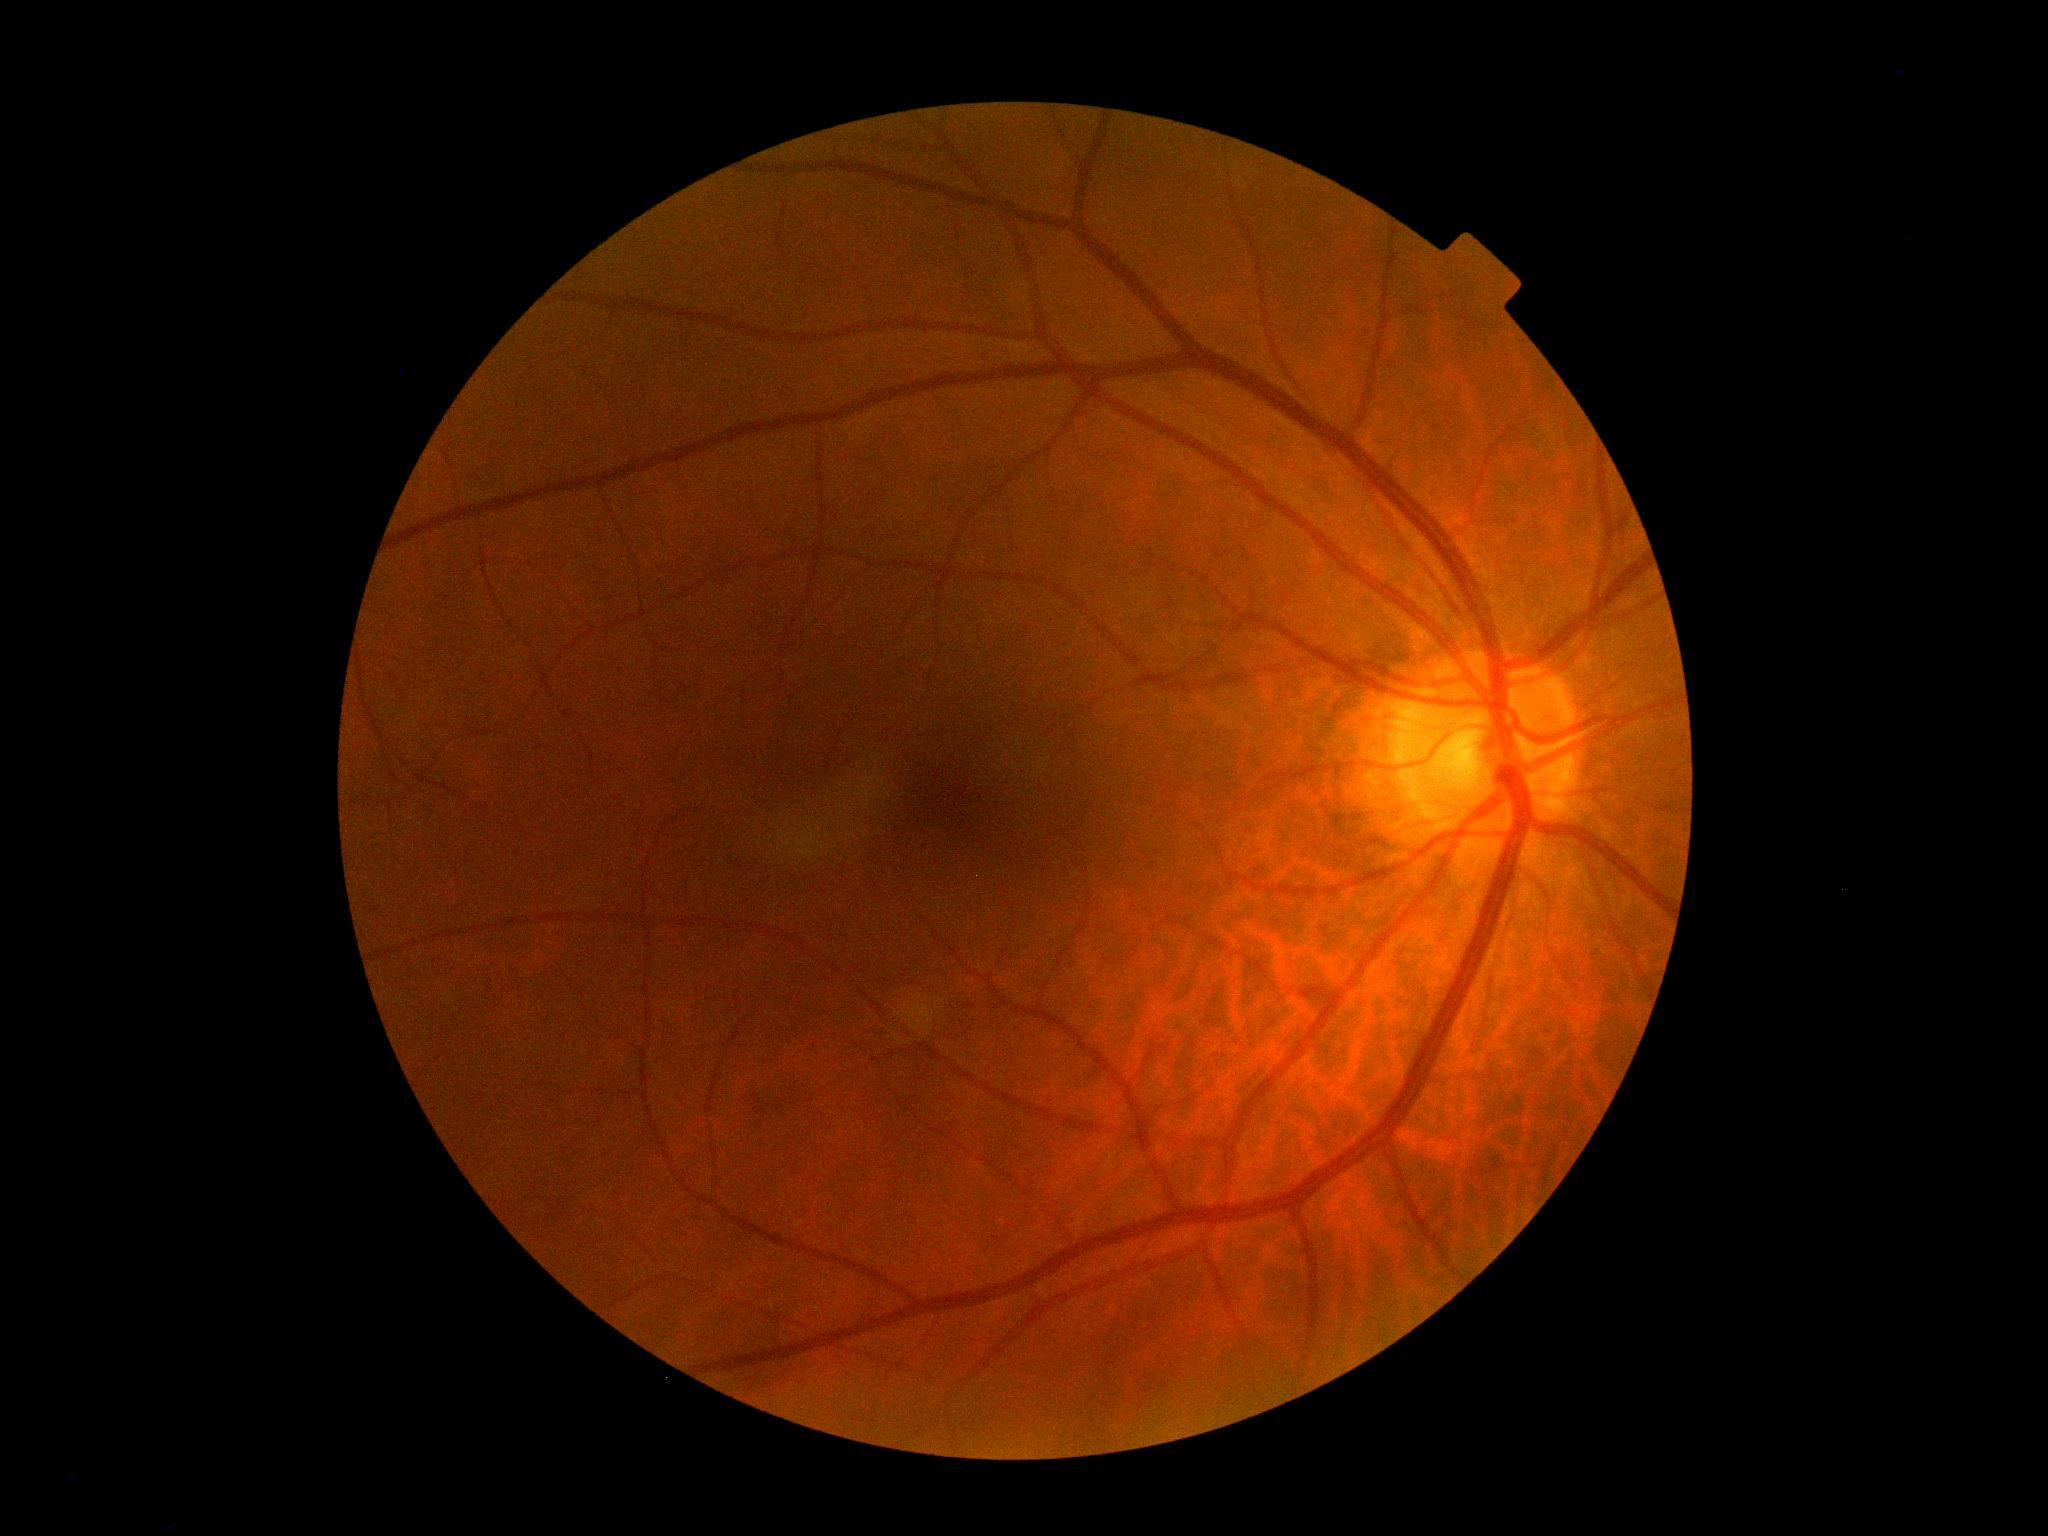
DR grade: no apparent retinopathy (0) — no visible signs of diabetic retinopathy. No diabetic retinal disease findings.